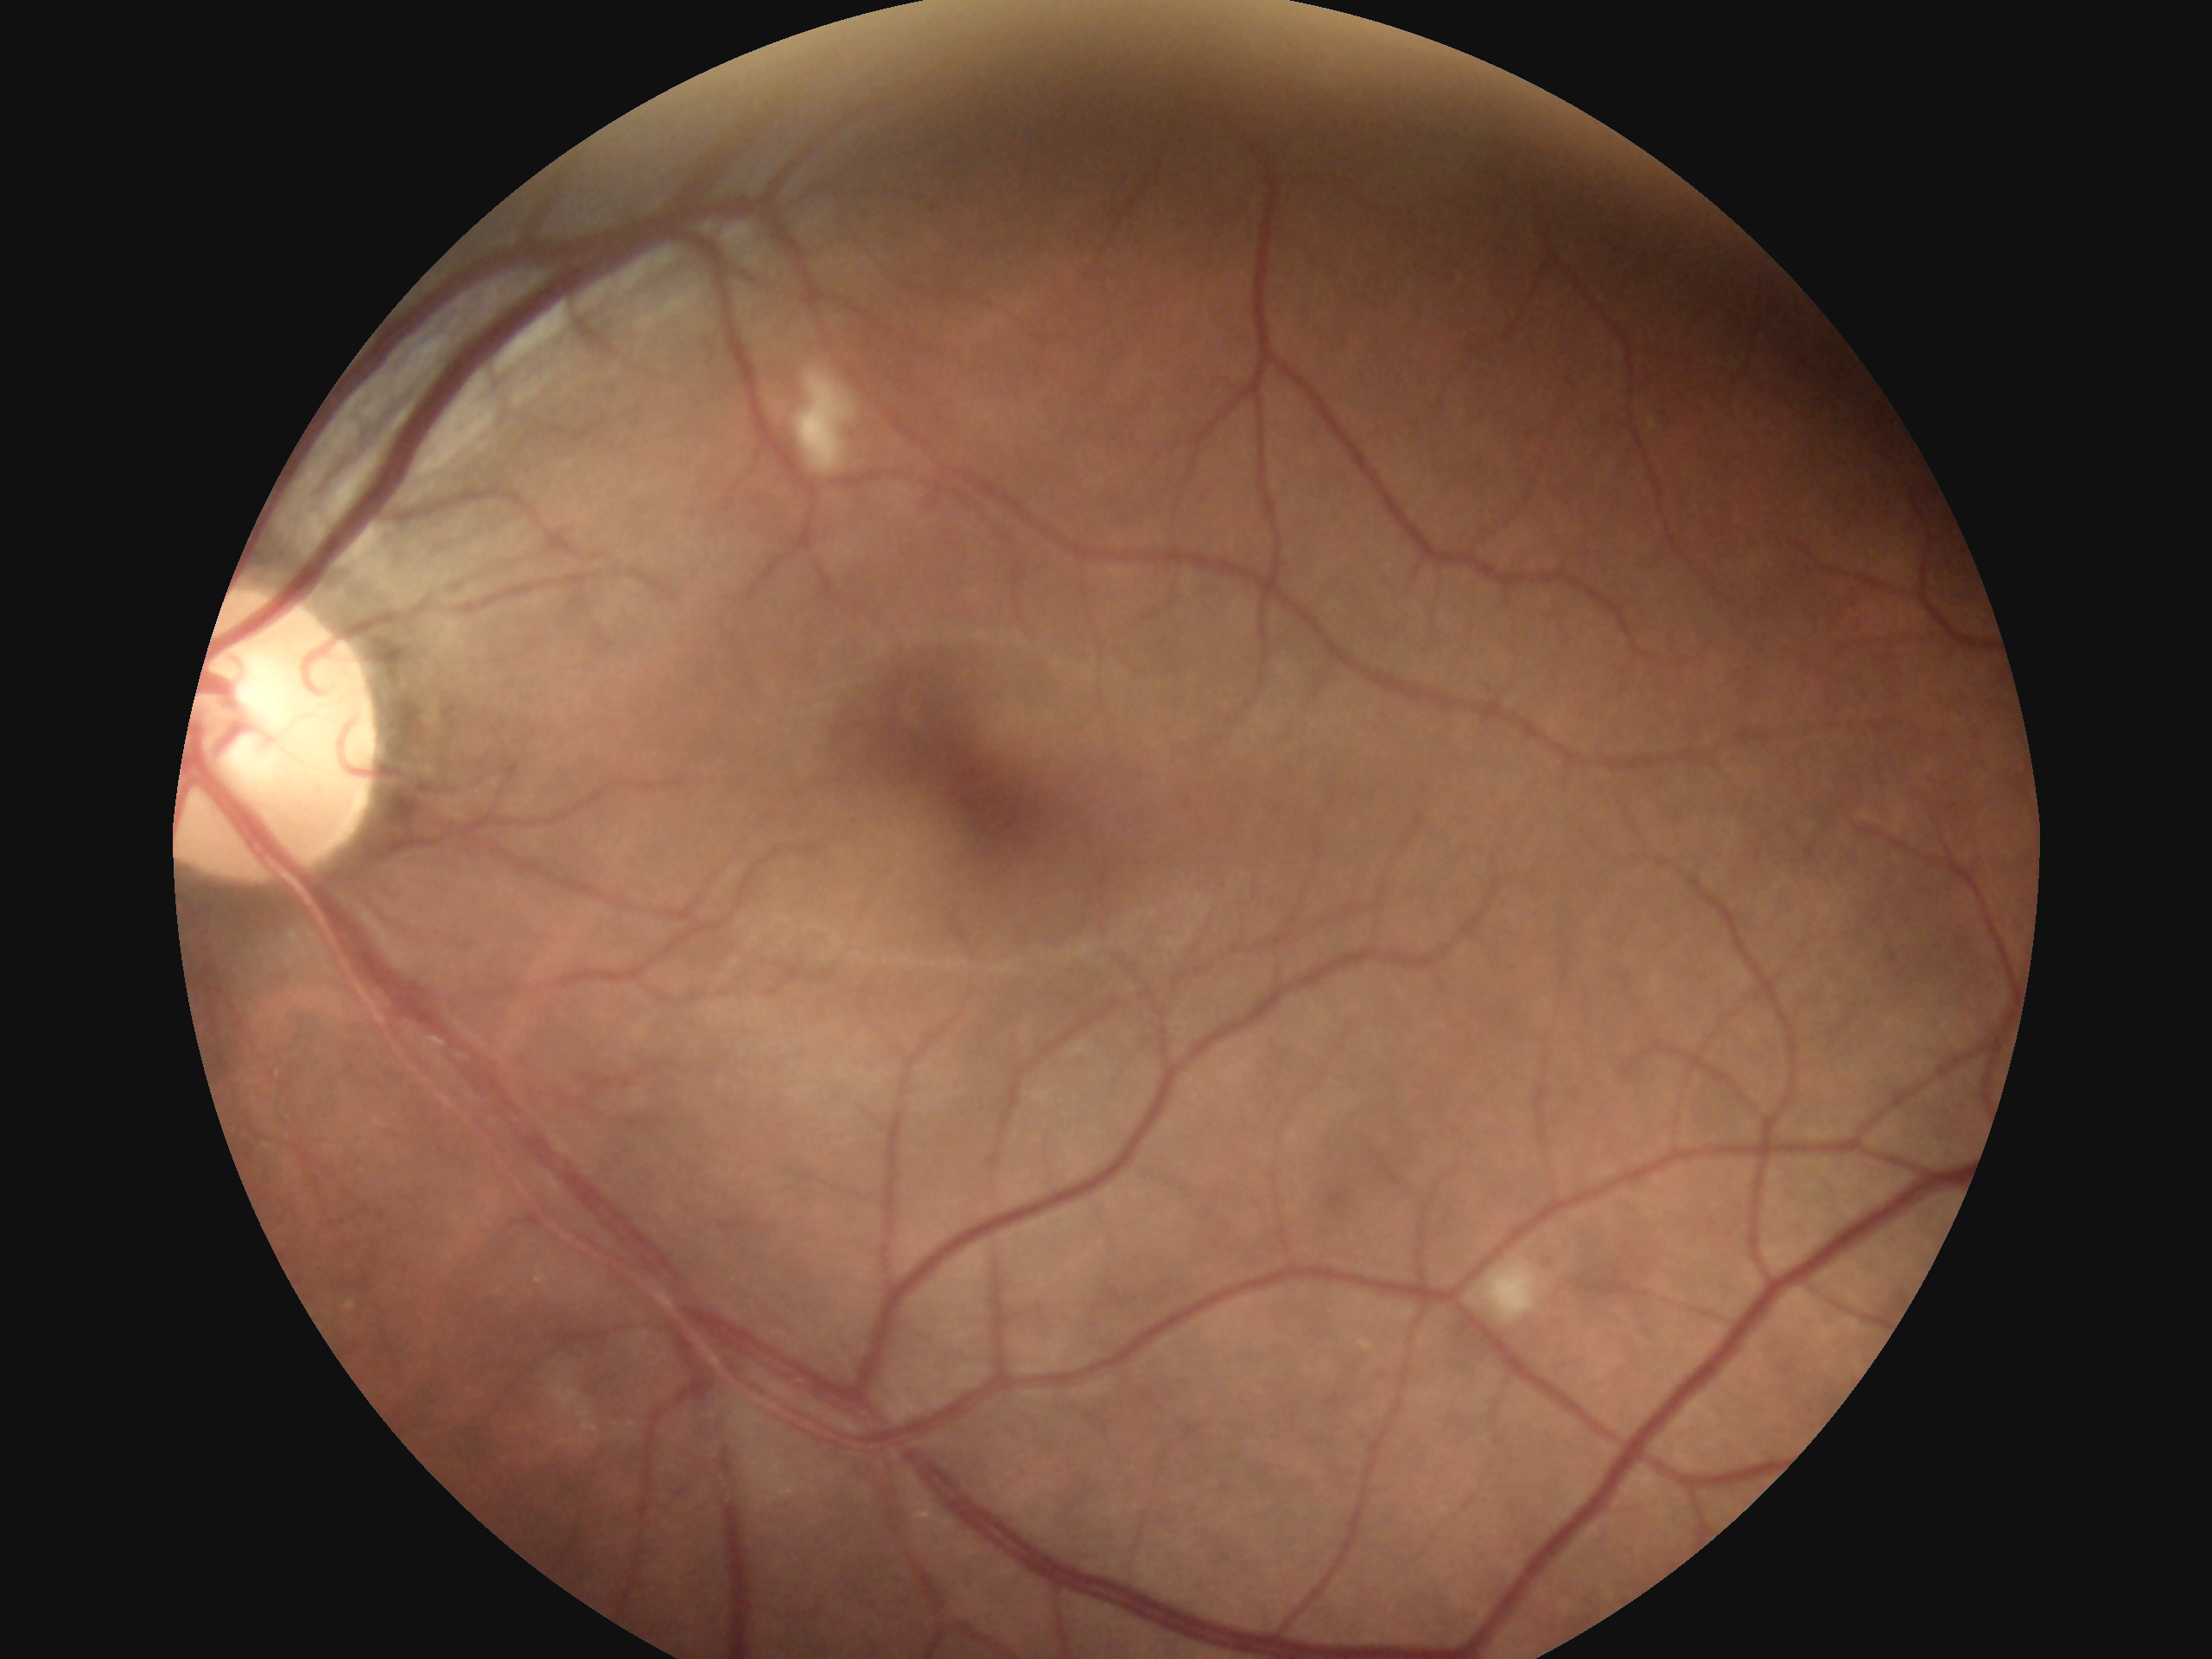

Annotations:
– retinopathy: grade 2 (moderate NPDR)